2228x1652 · retinal fundus photograph · pupil-dilated · 50° field of view:
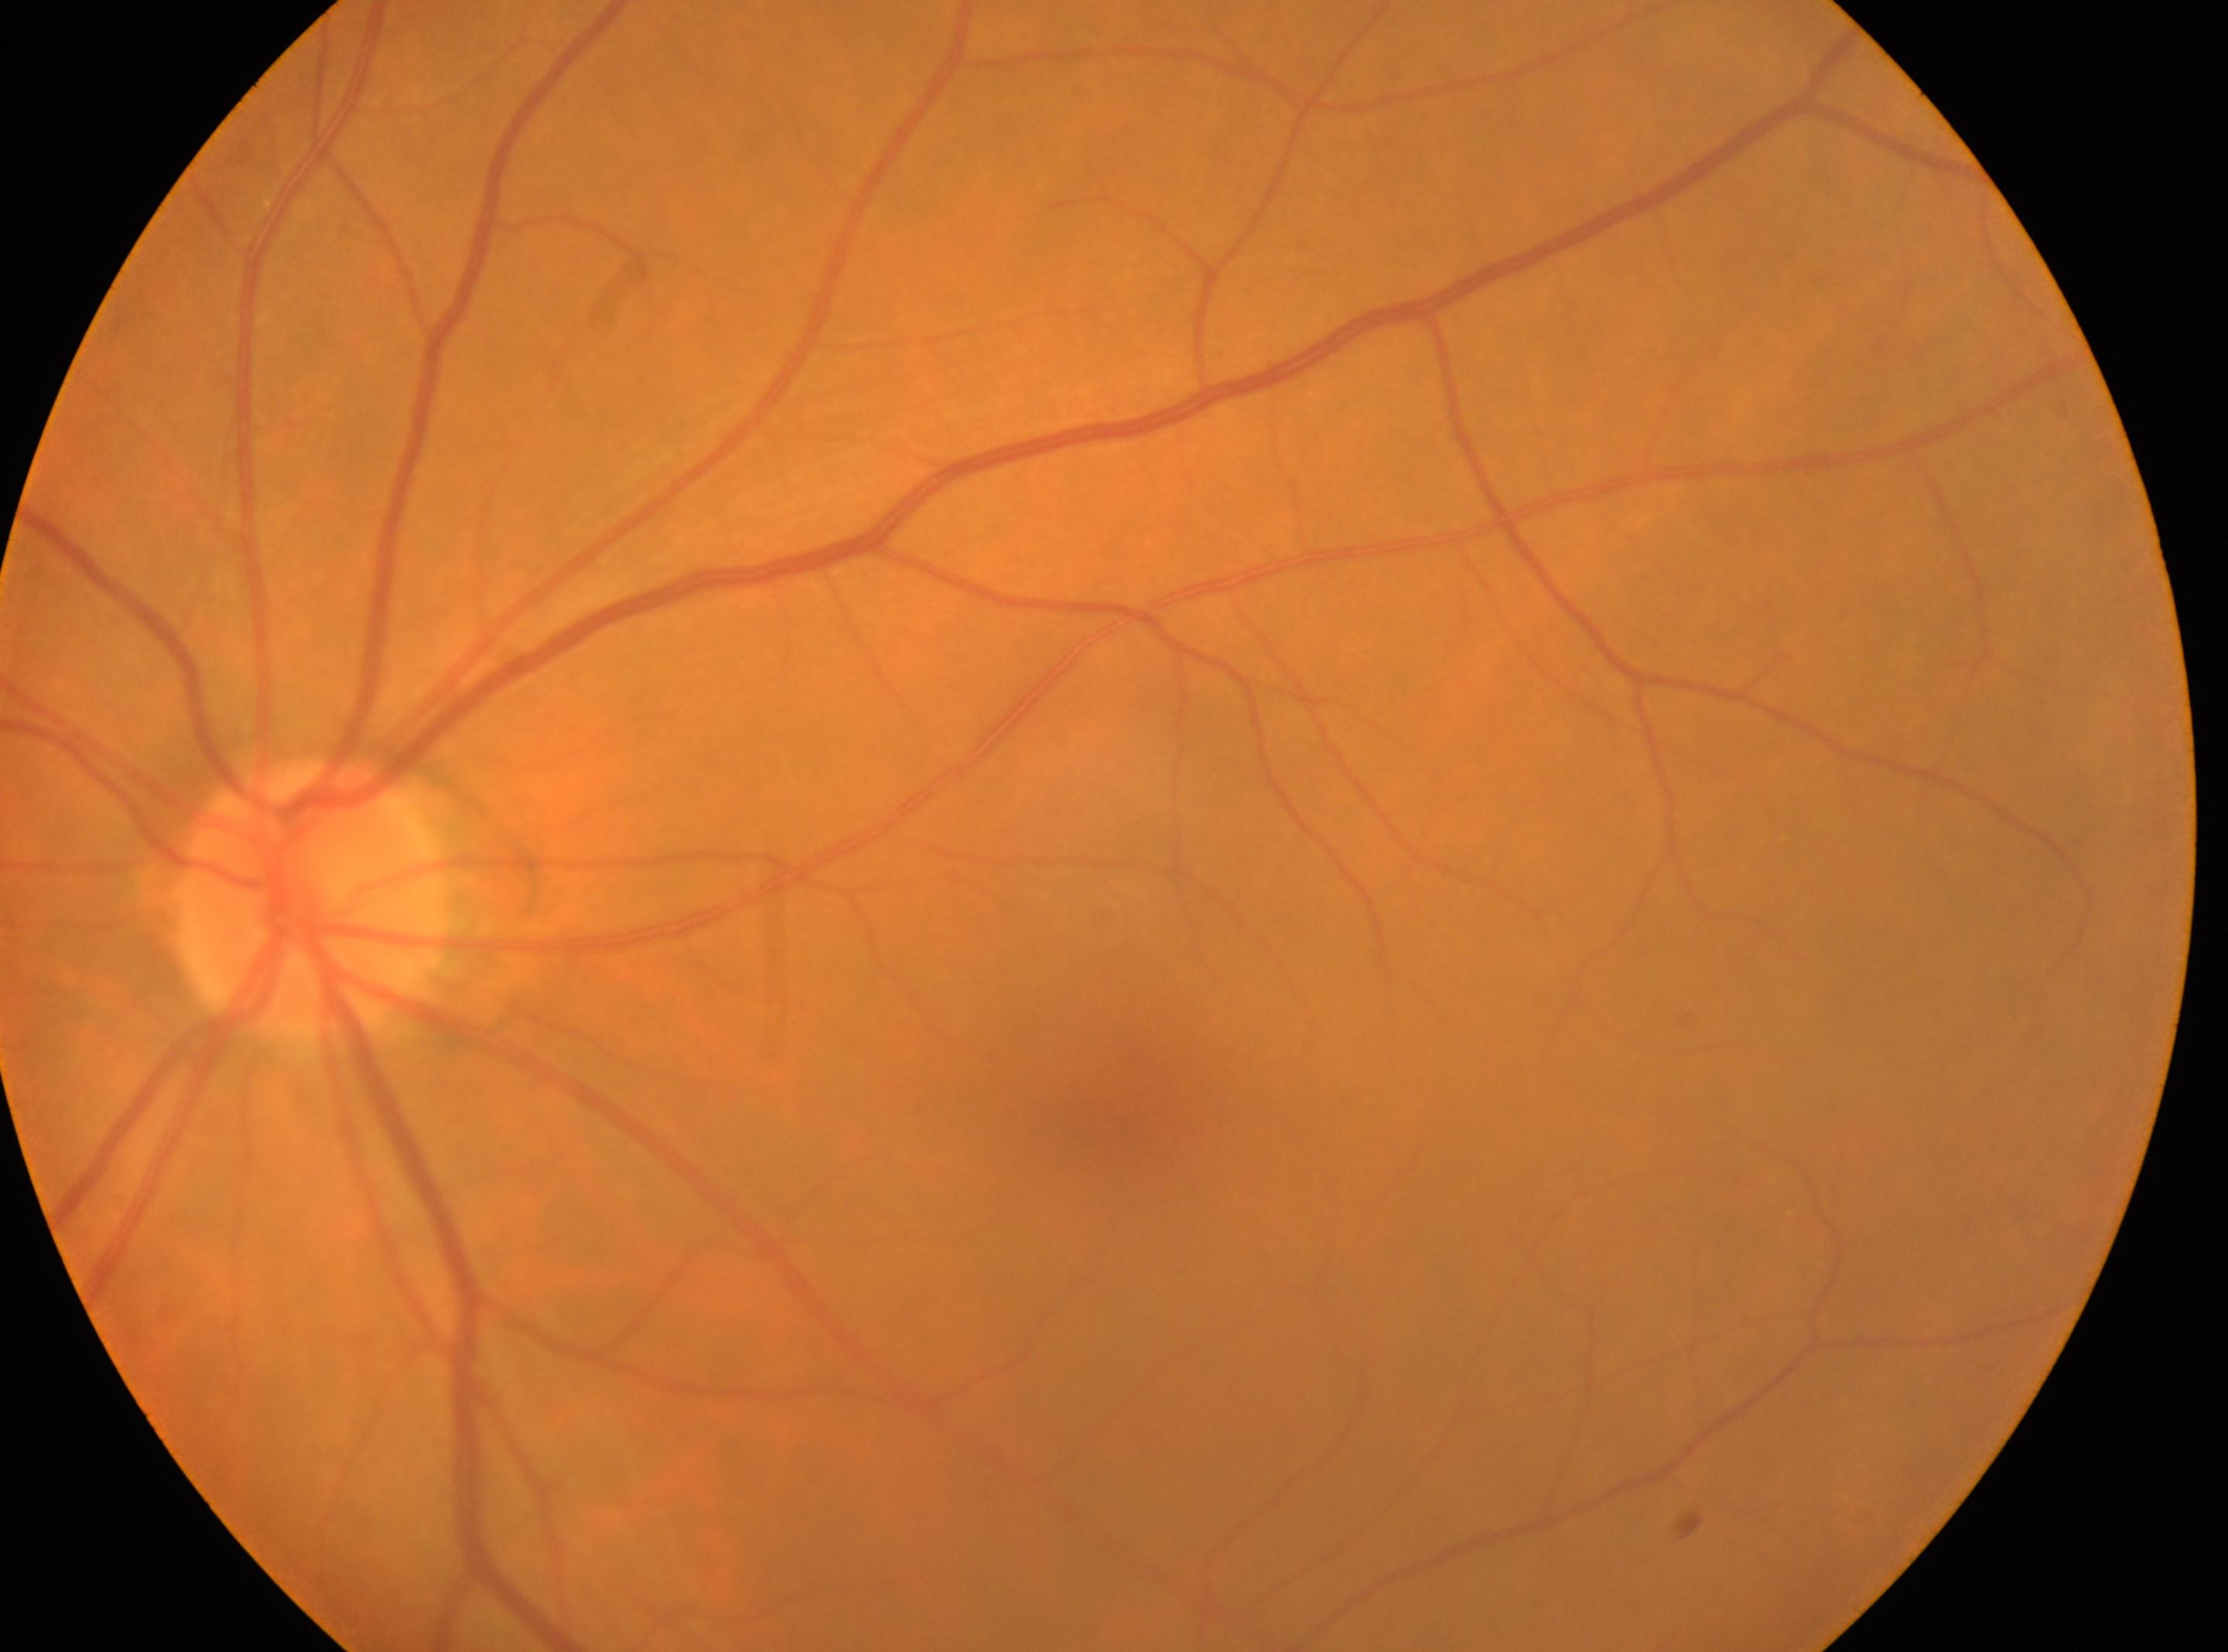 * fovea centralis: (x=1137, y=1115)
* laterality: left
* DR grade: 0
* ONH: (x=311, y=900)